Modified Davis classification, 45-degree field of view, acquired with a NIDEK AFC-230, posterior pole color fundus photograph
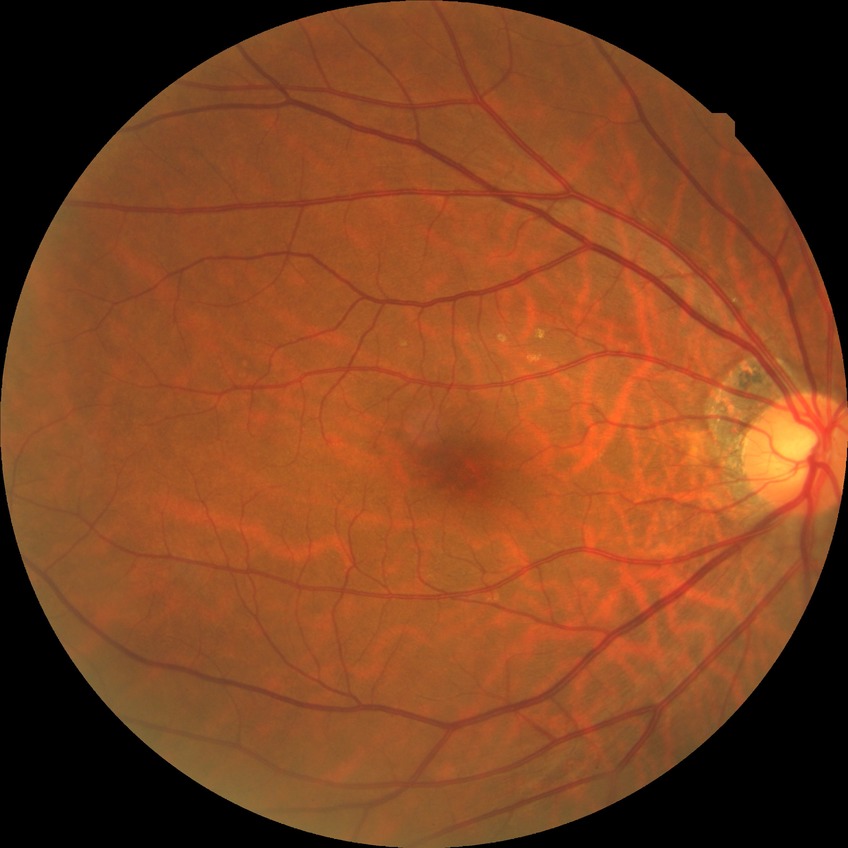
Diabetic retinopathy severity: no diabetic retinopathy.